Davis DR grading
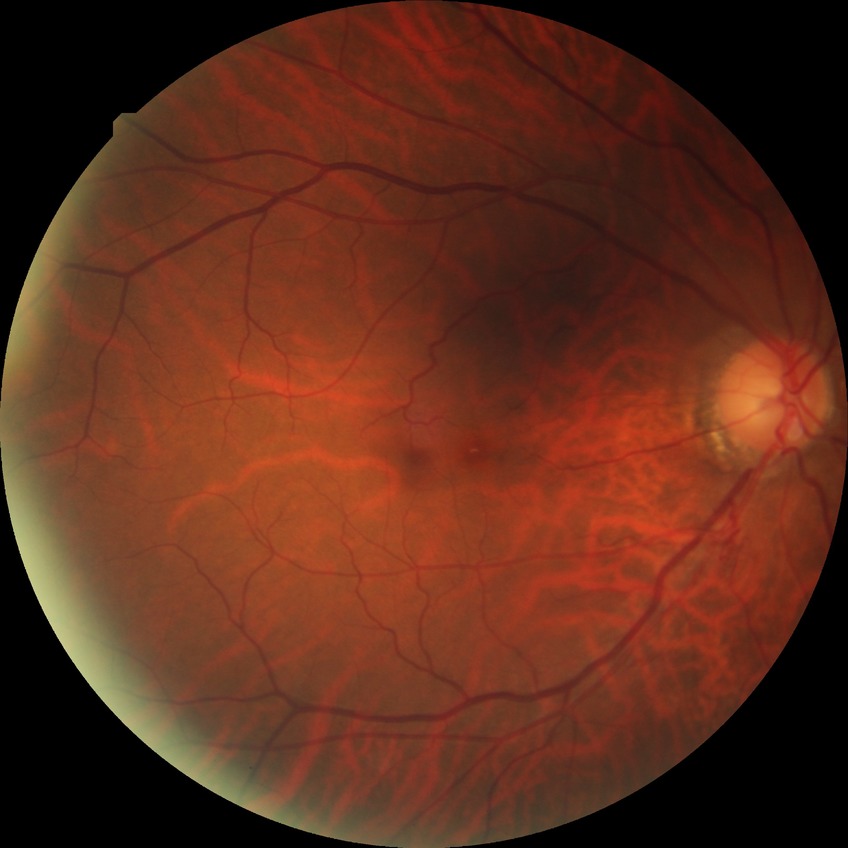
Diabetic retinopathy (DR) is no diabetic retinopathy (NDR).